Pediatric wide-field fundus photograph. Acquired on the Natus RetCam Envision — 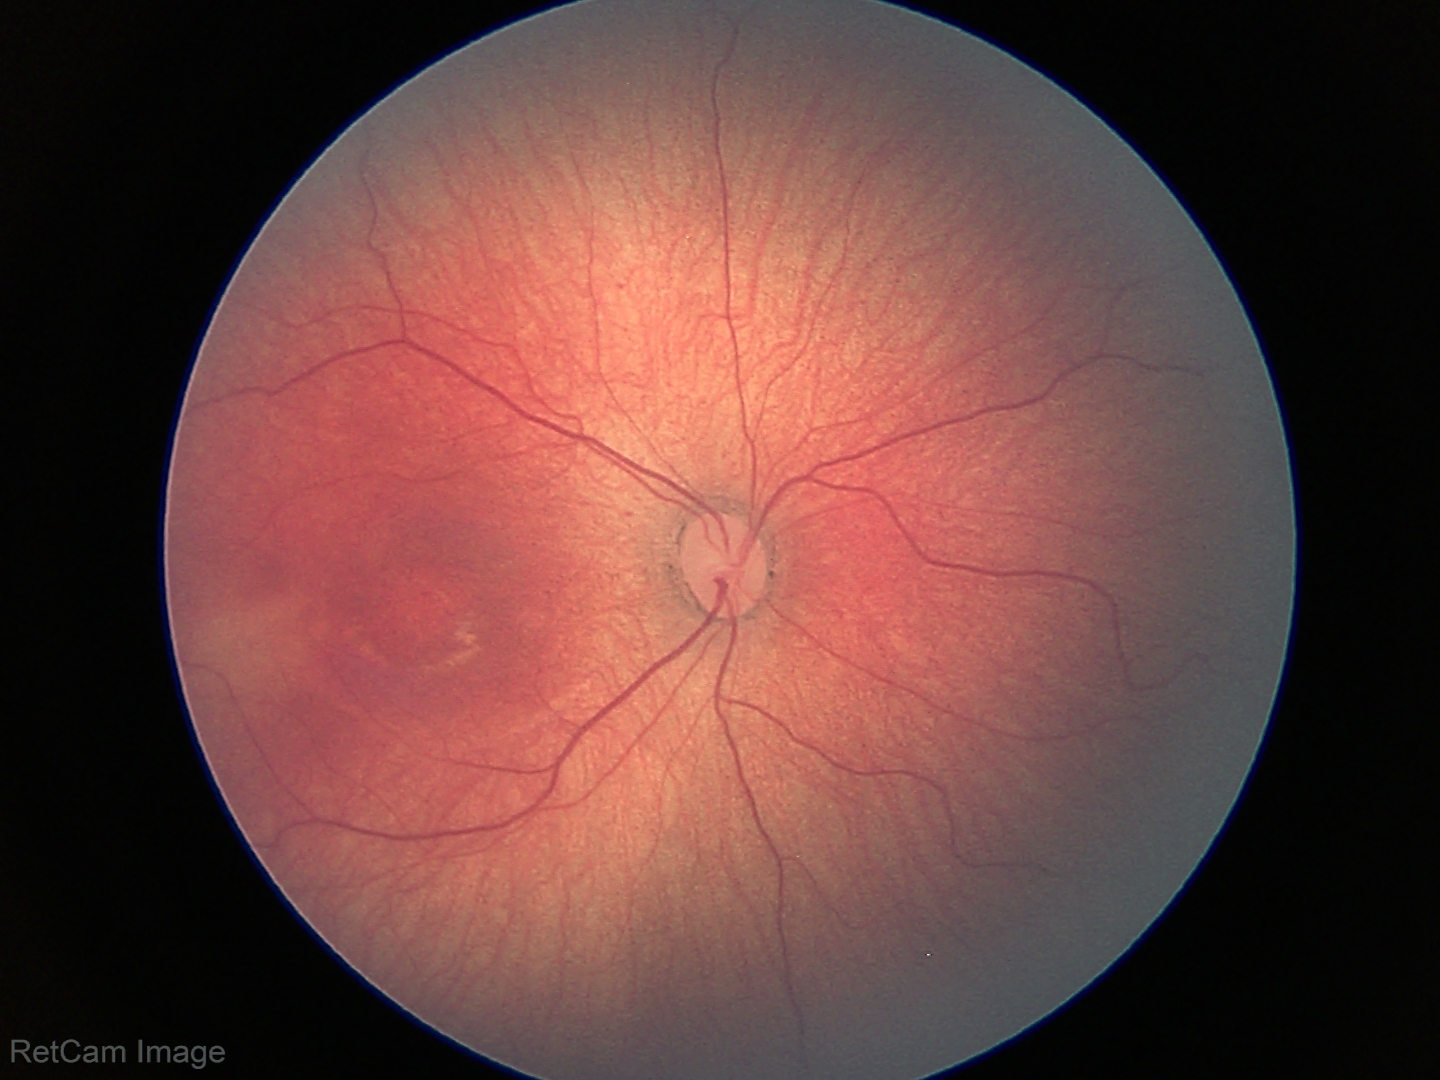
Q: What is the screening diagnosis?
A: retinopathy of prematurity stage 2